Captured with the Phoenix ICON (100° field of view) · 1240x1240px · wide-field fundus photograph of an infant
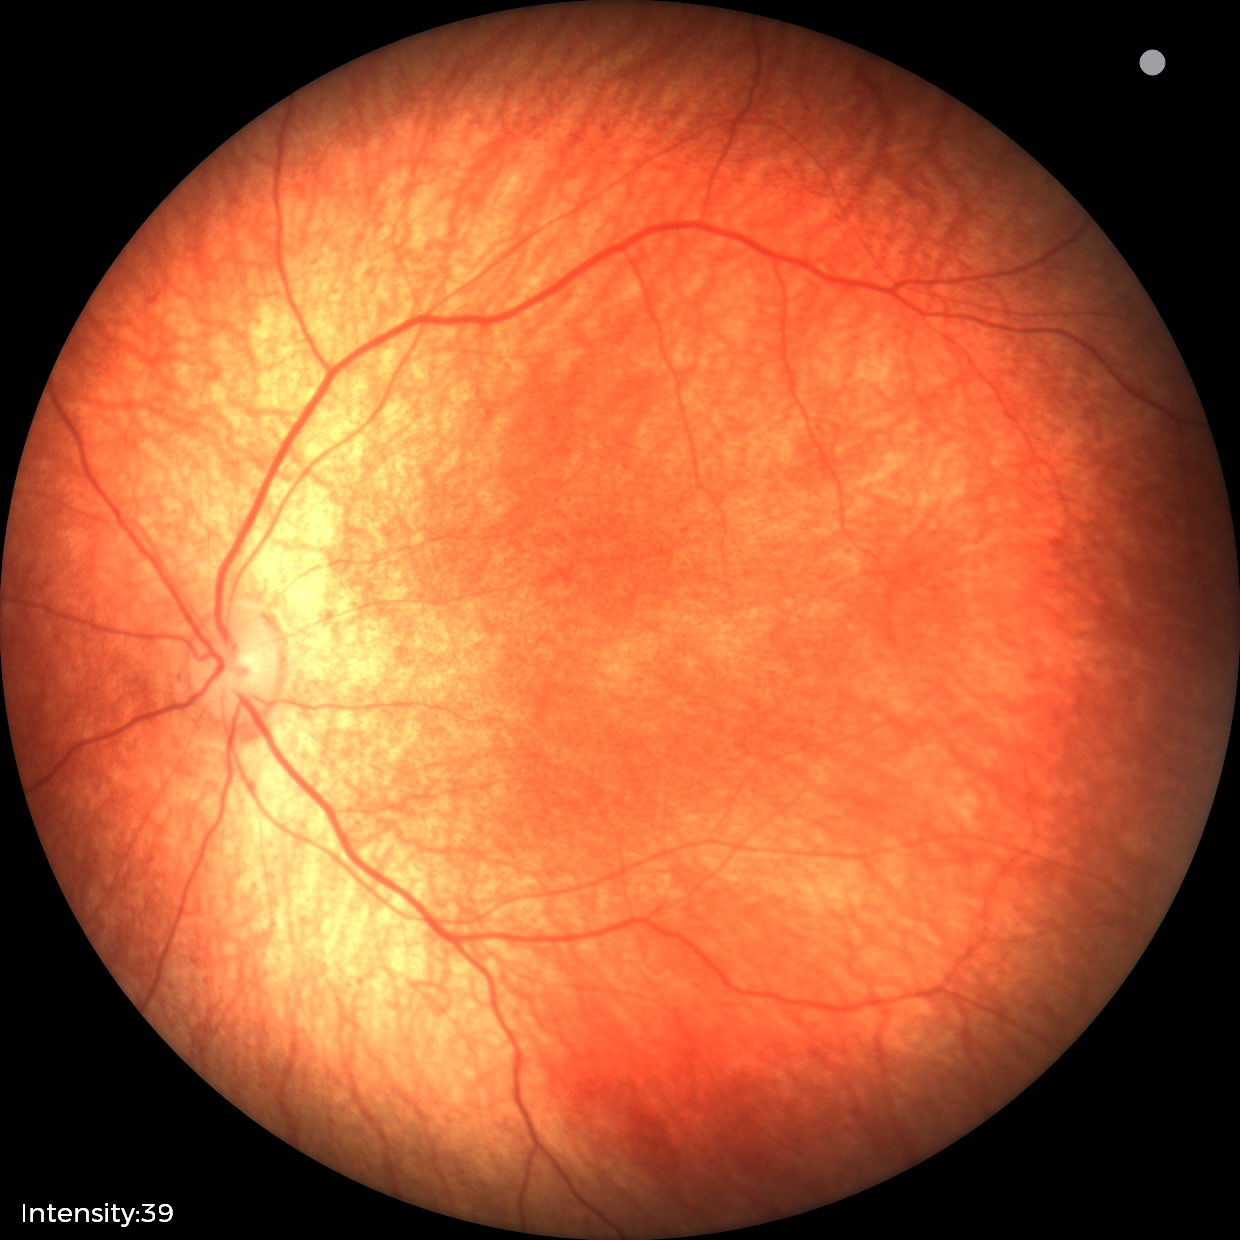

Normal screening examination.